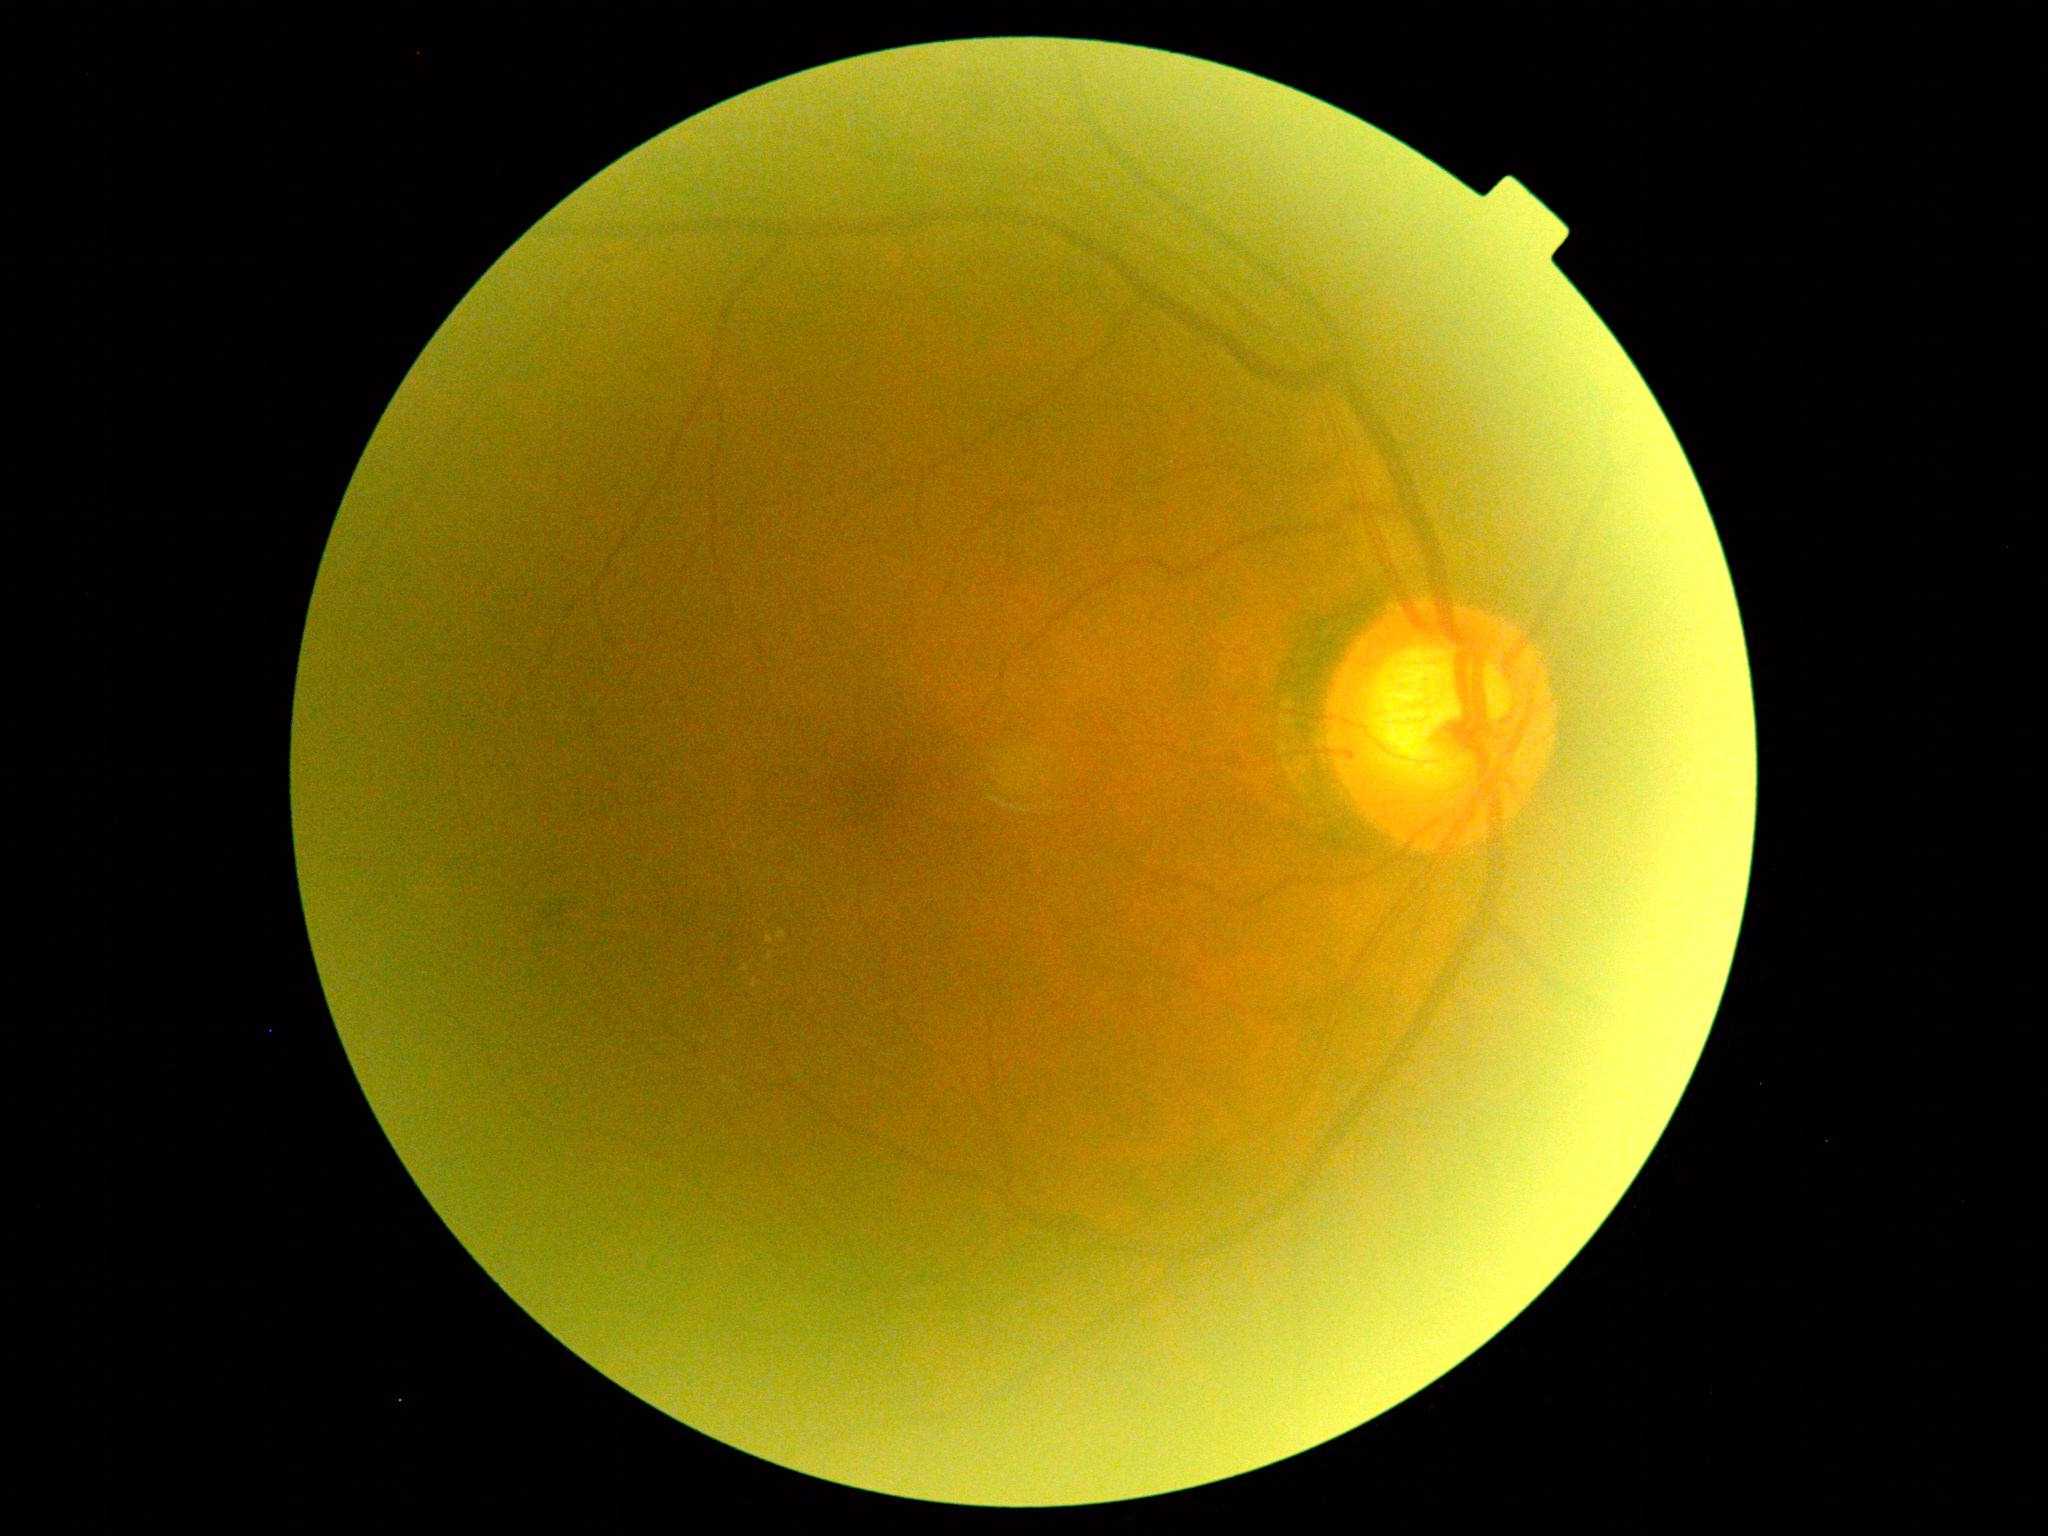

Retinopathy grade is 2.